60-degree field of view
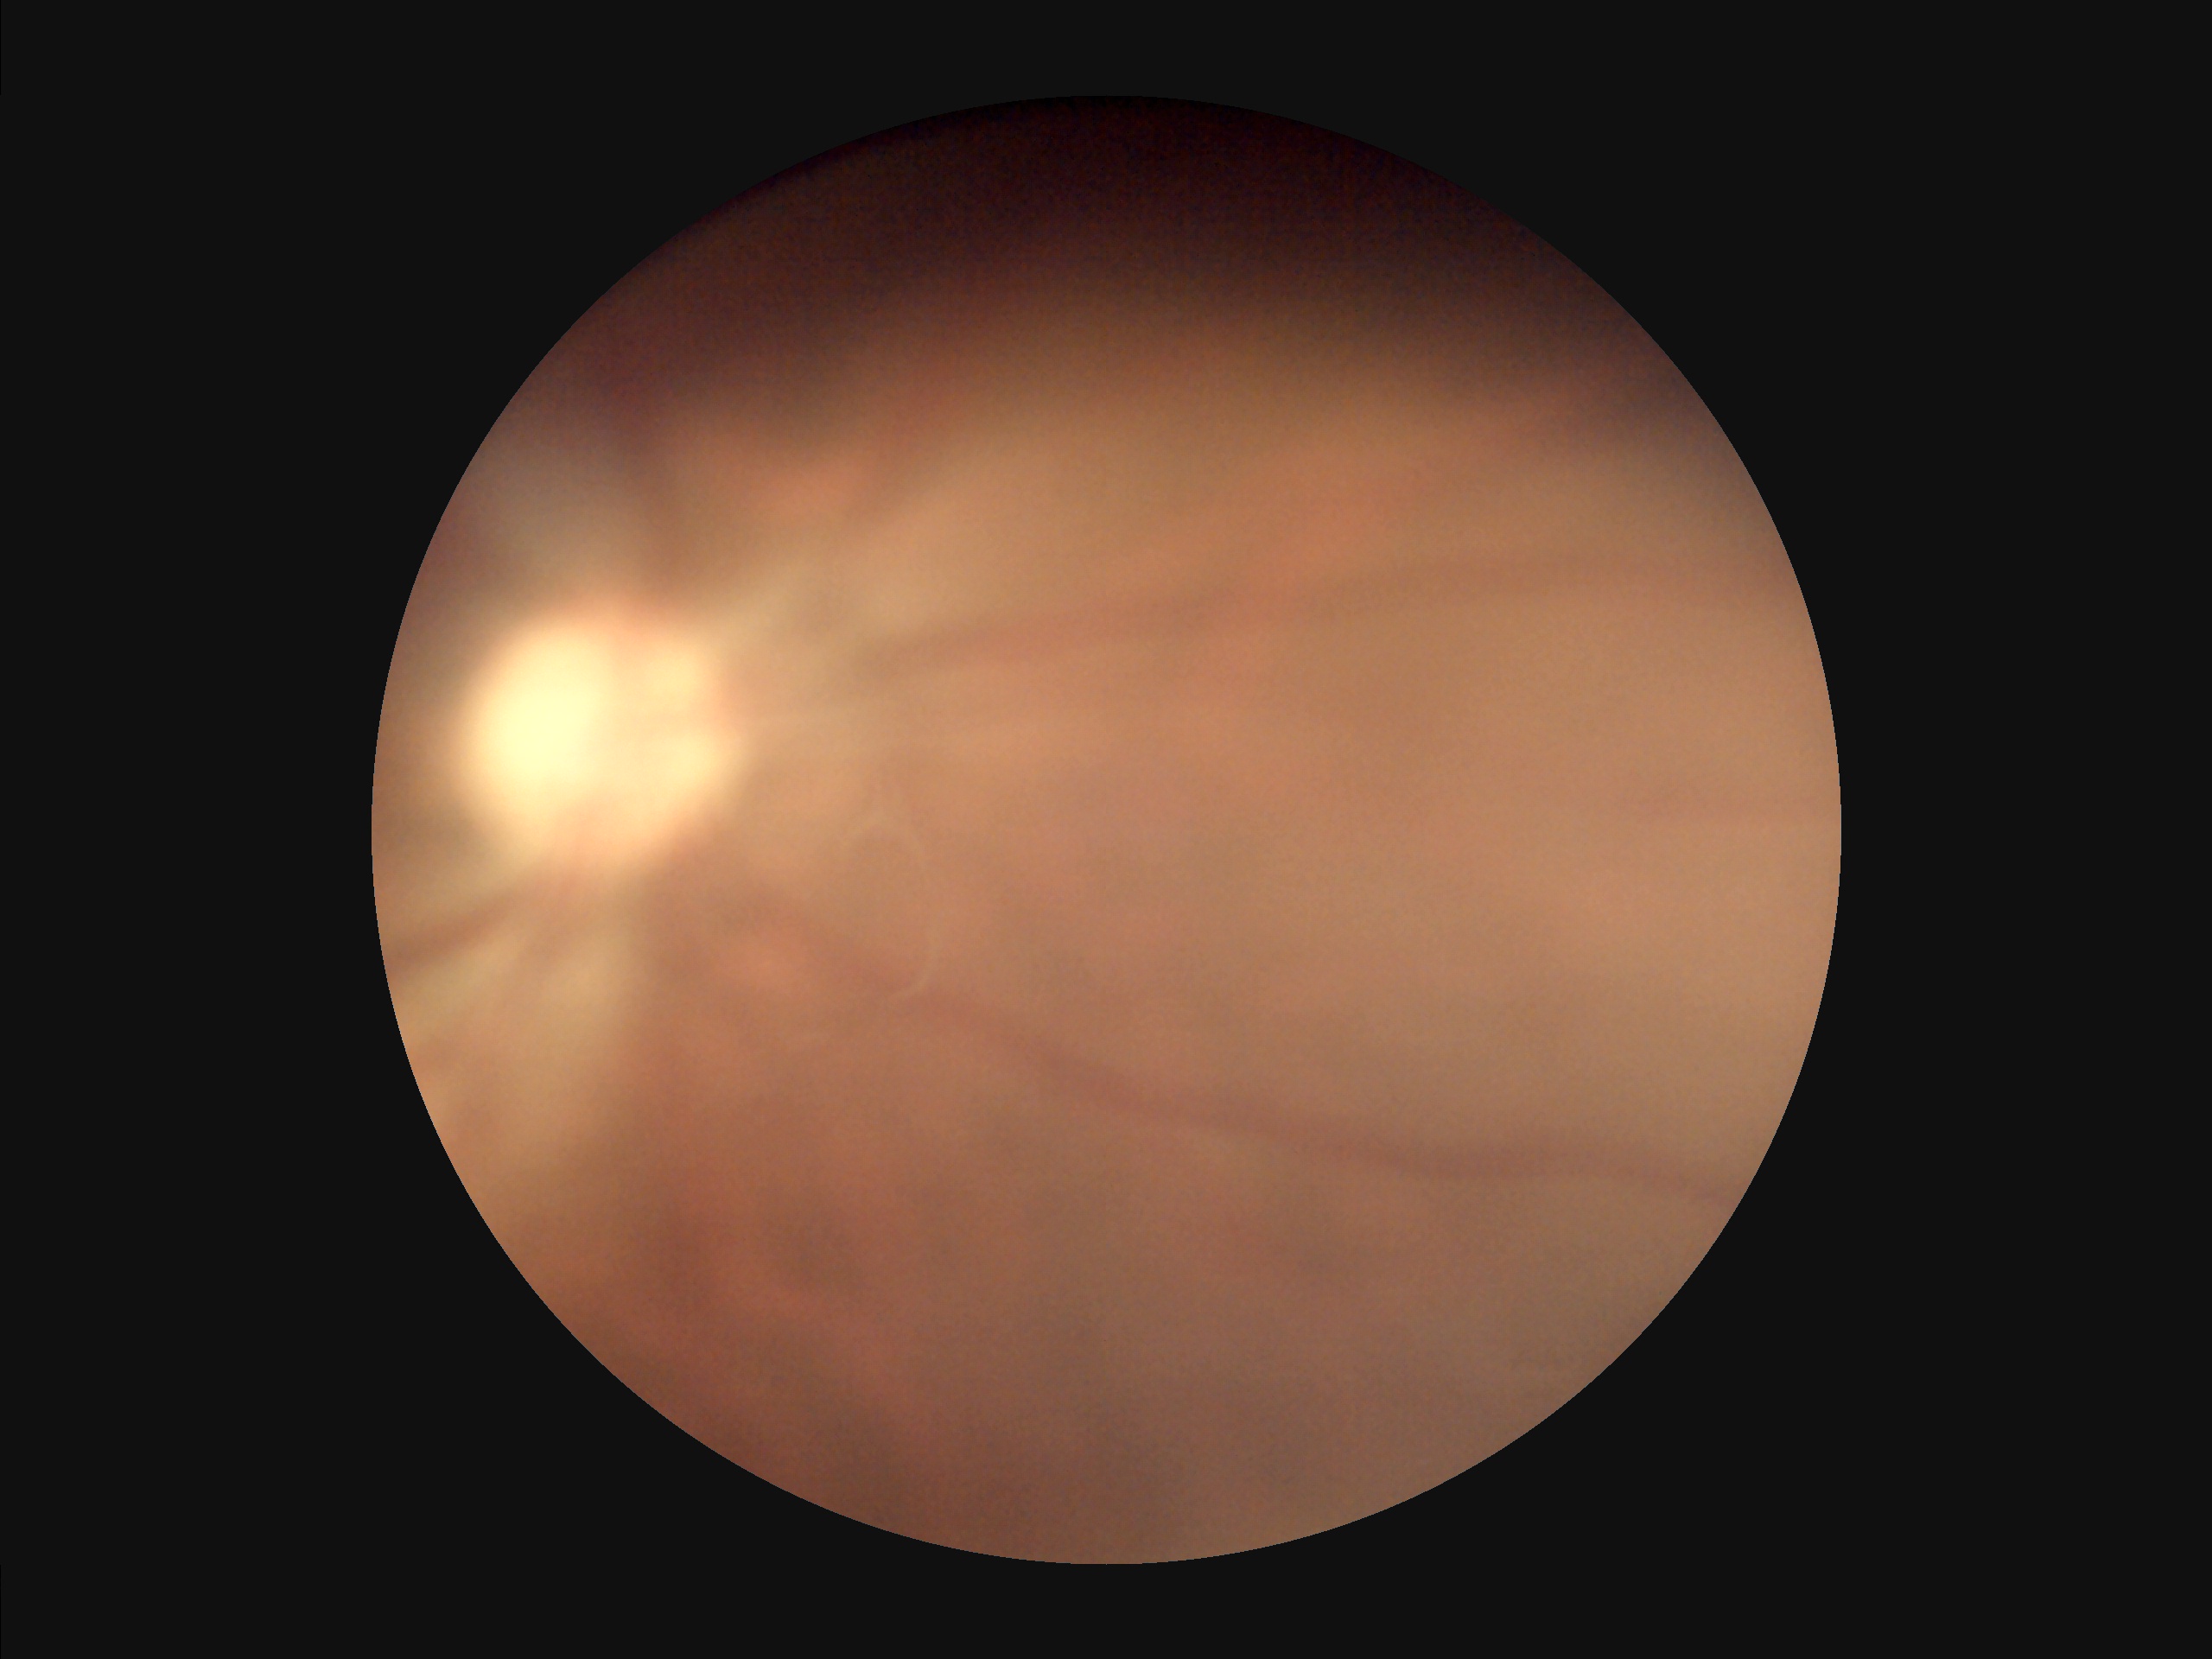

  illumination: over- or under-exposed
  overall_quality: poor, ungradable
  contrast: vessels and details readily distinguishable
  clarity: noticeable blur in the optic disc, vessels, or background